Color fundus image. 2048 by 1536 pixels.
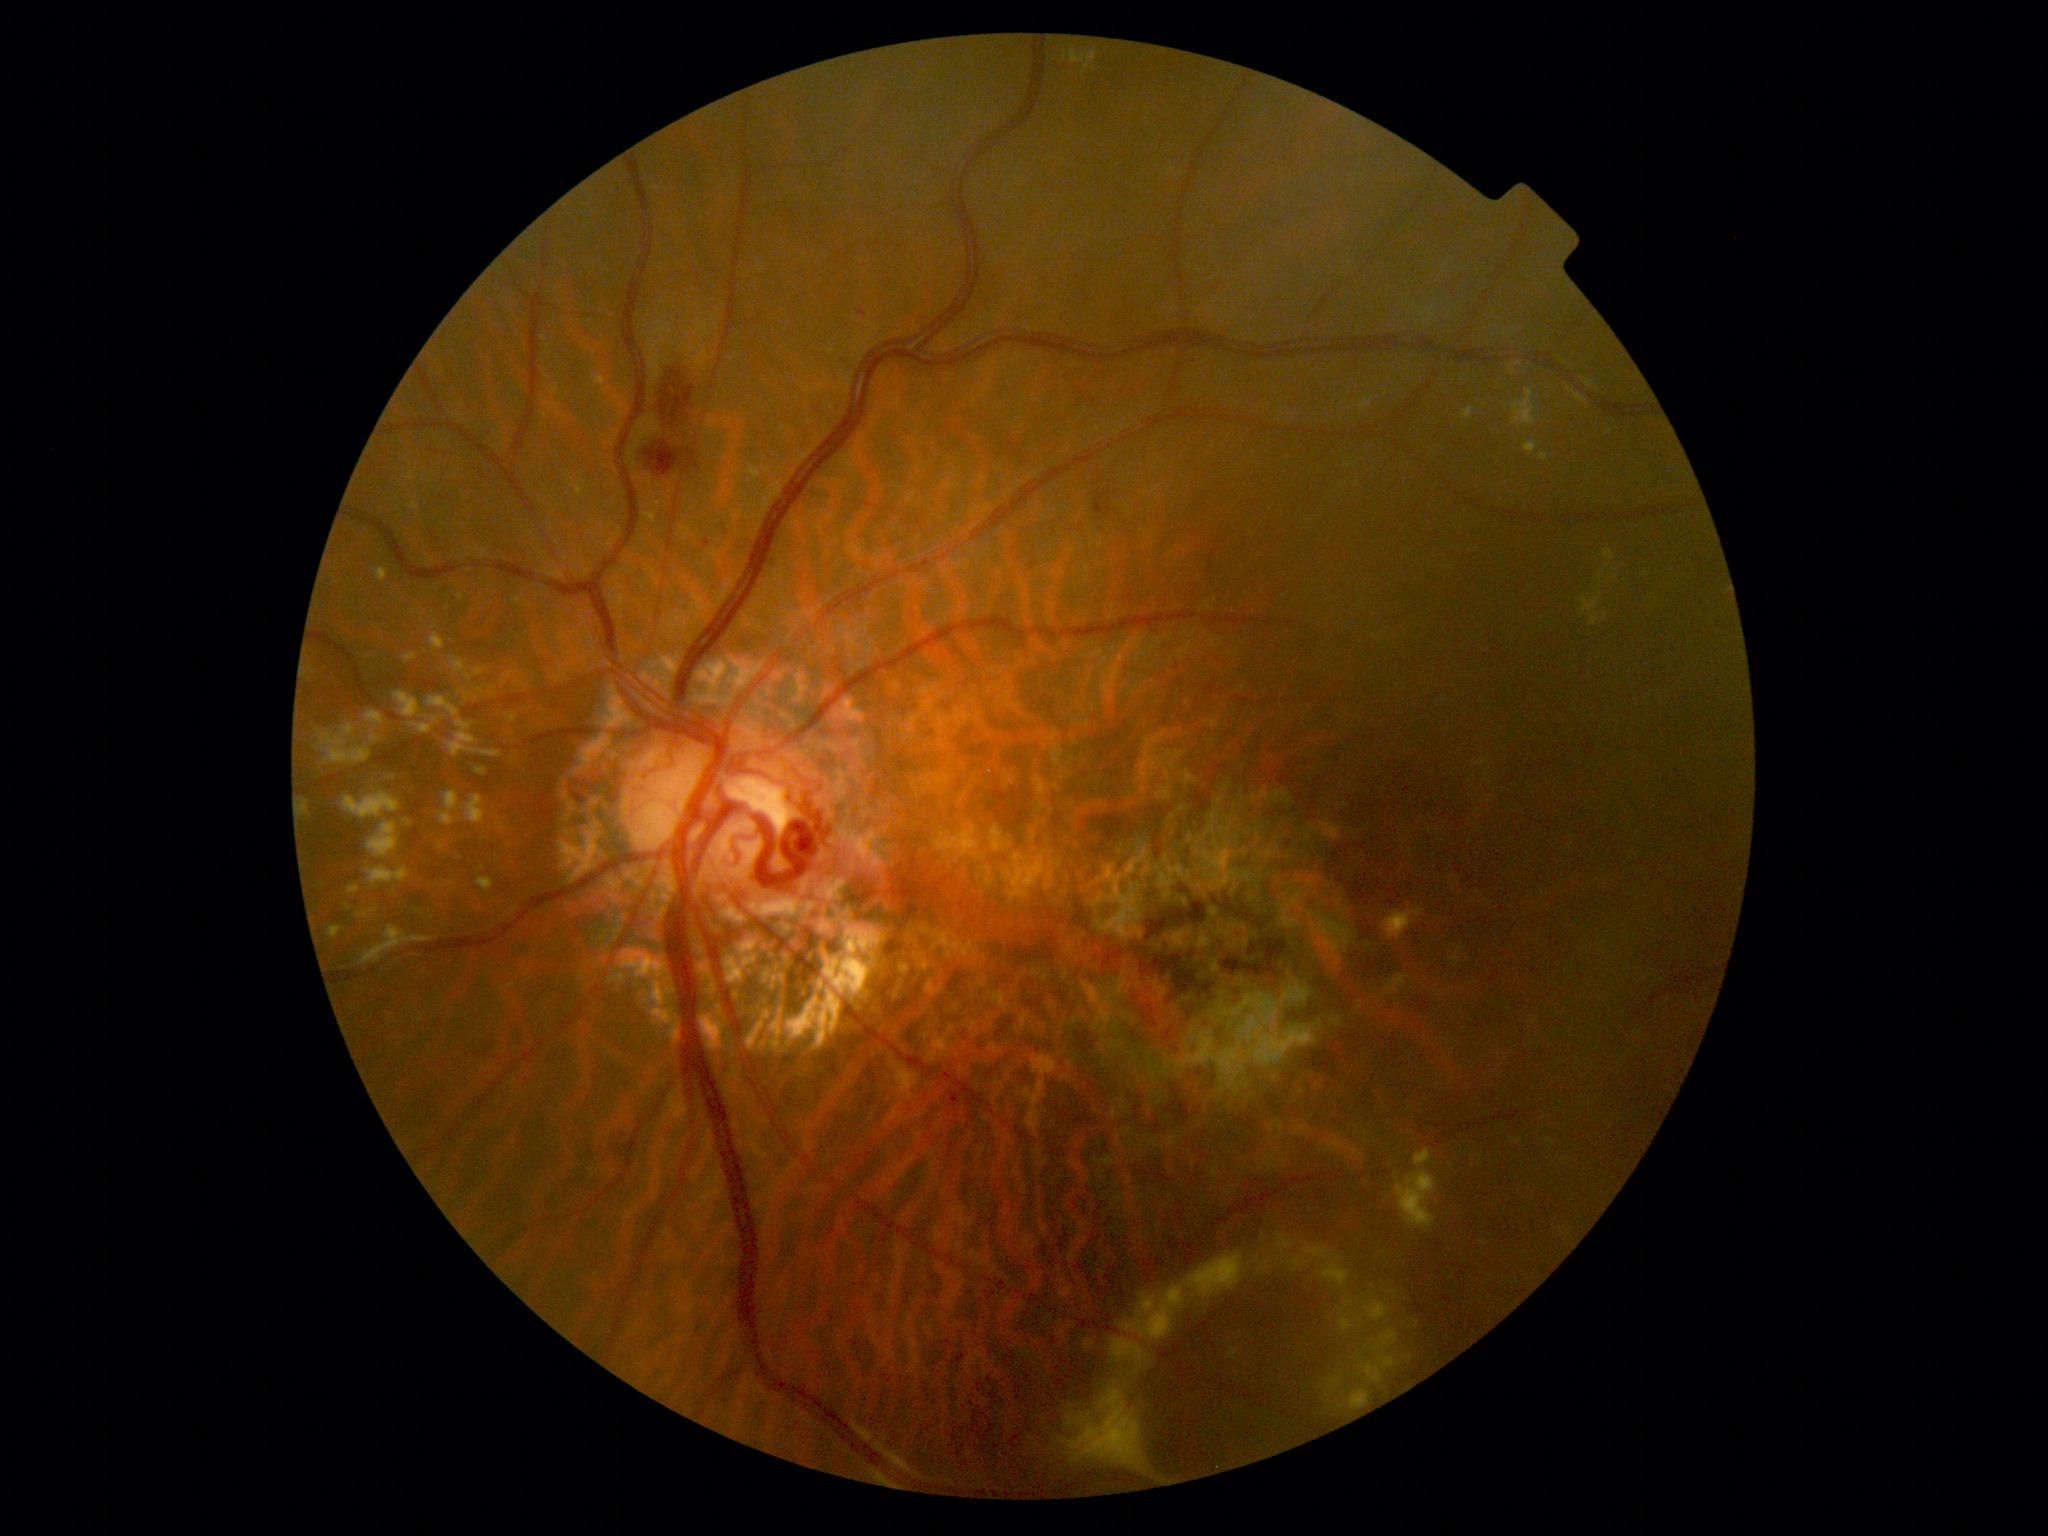

Diabetic retinopathy: 2
Lesions identified (partial list):
hard exudates (more not shown) = {"x1": 357, "y1": 908, "x2": 378, "y2": 919}; {"x1": 1169, "y1": 1286, "x2": 1184, "y2": 1304}; {"x1": 1464, "y1": 408, "x2": 1474, "y2": 421}; {"x1": 407, "y1": 473, "x2": 416, "y2": 481}; {"x1": 1278, "y1": 1243, "x2": 1350, "y2": 1289}; {"x1": 1377, "y1": 1329, "x2": 1400, "y2": 1349}; {"x1": 1277, "y1": 1234, "x2": 1295, "y2": 1254}; {"x1": 394, "y1": 692, "x2": 417, "y2": 719}; {"x1": 430, "y1": 634, "x2": 443, "y2": 650}; {"x1": 1414, "y1": 1176, "x2": 1437, "y2": 1193}; {"x1": 320, "y1": 723, "x2": 371, "y2": 765}; {"x1": 367, "y1": 822, "x2": 400, "y2": 859}; {"x1": 366, "y1": 710, "x2": 387, "y2": 730}; {"x1": 376, "y1": 568, "x2": 388, "y2": 583}; {"x1": 1605, "y1": 550, "x2": 1615, "y2": 561}; {"x1": 367, "y1": 866, "x2": 410, "y2": 885}; {"x1": 1524, "y1": 442, "x2": 1537, "y2": 454}
Additional small hard exudates near 442/848